Non-mydriatic fundus camera: 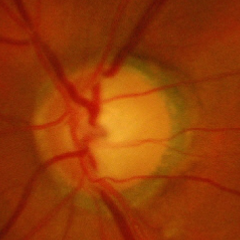
Glaucoma is present.
Severe glaucomatous damage.